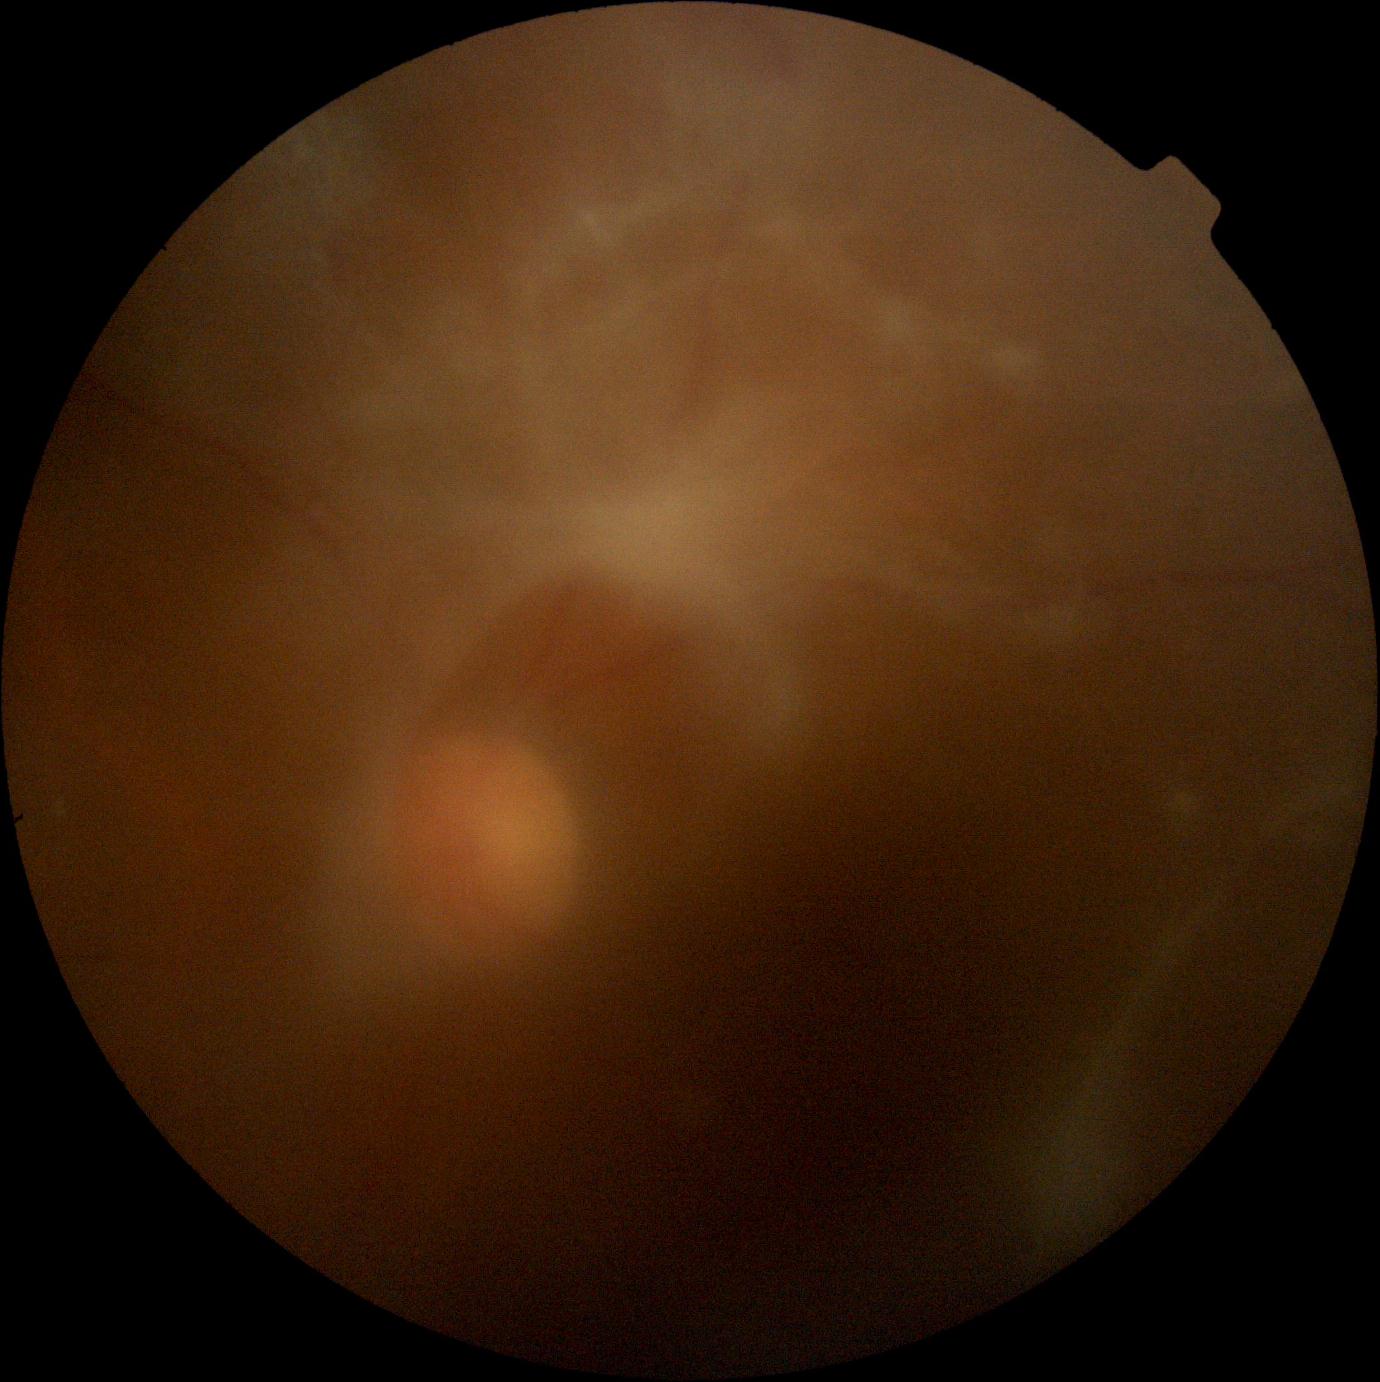 retinopathy grade: 4/4.